848x848 · camera: NIDEK AFC-230 · without pupil dilation · 45° field of view · DR severity per modified Davis staging · CFP — 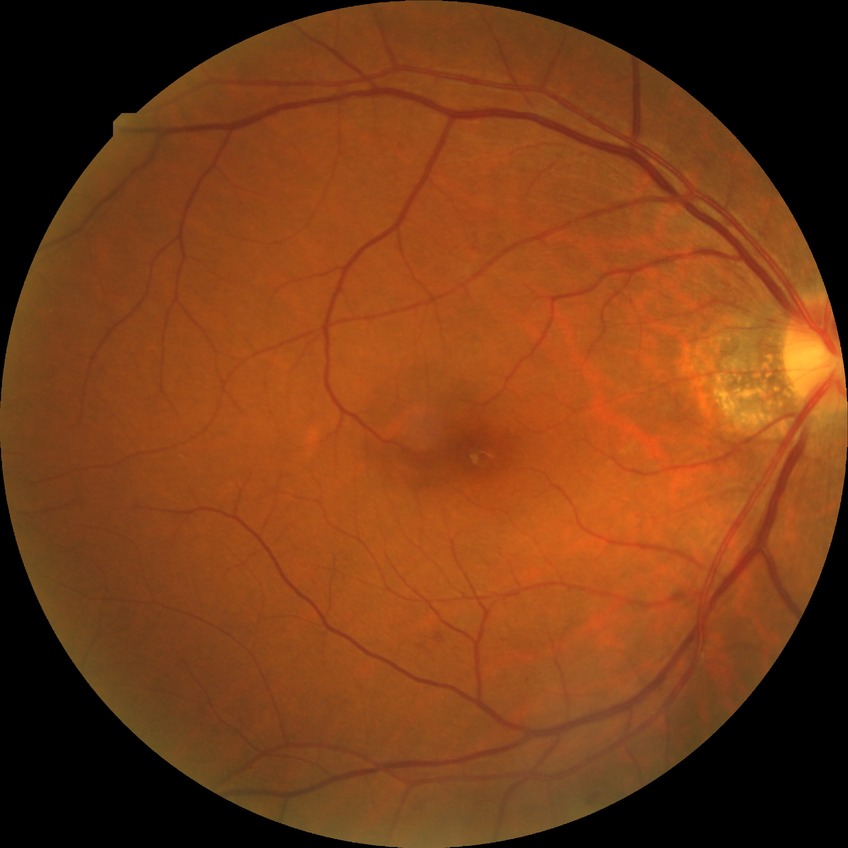 Findings:
– diabetic retinopathy (DR) — SDR (simple diabetic retinopathy)